Graded on the modified Davis scale · NIDEK AFC-230 fundus camera.
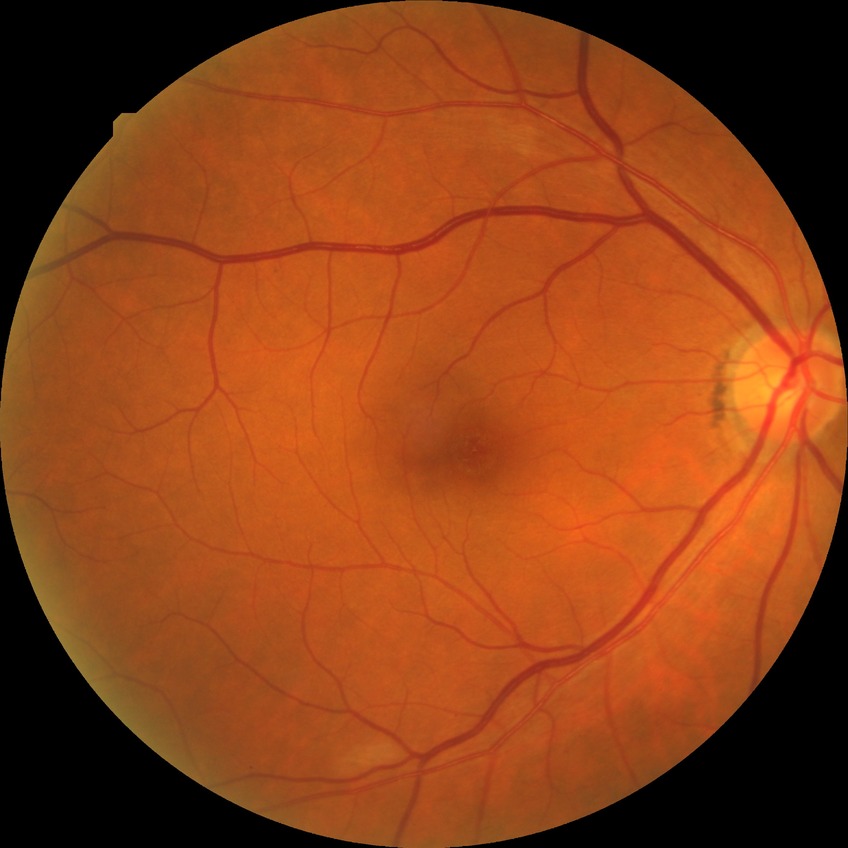
DR severity: SDR.